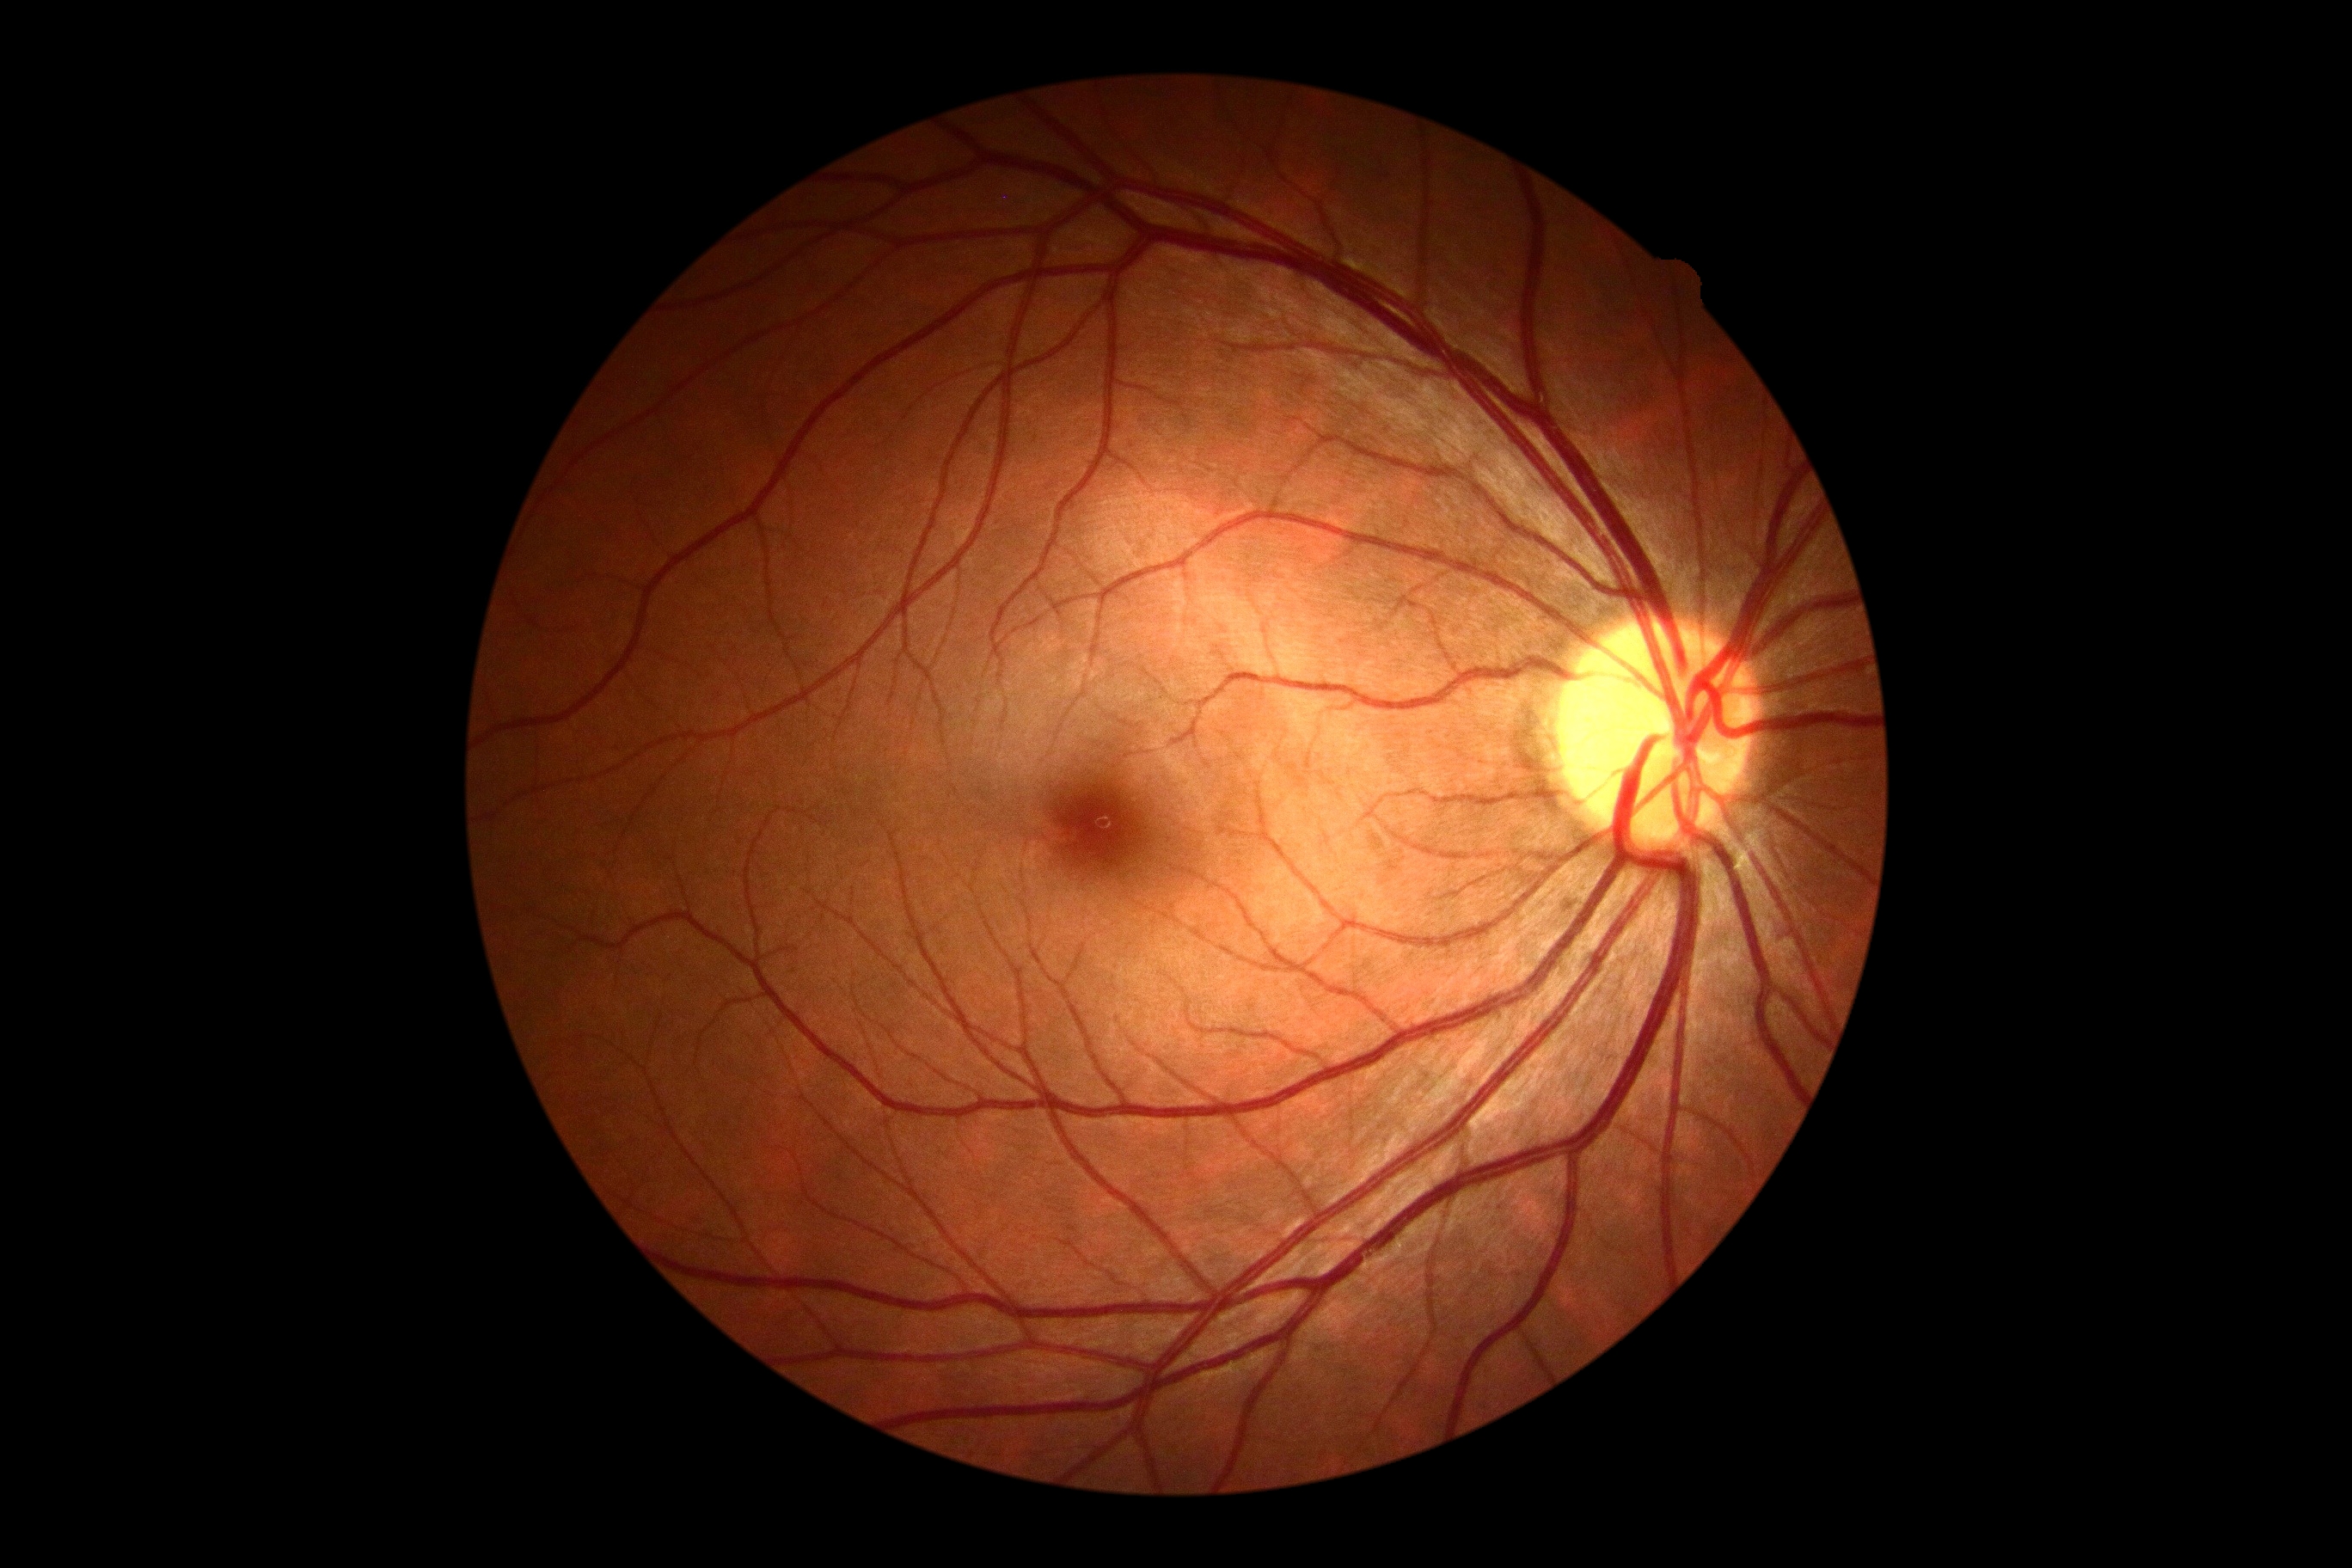 DR stage is no apparent retinopathy (grade 0) — no visible signs of diabetic retinopathy.